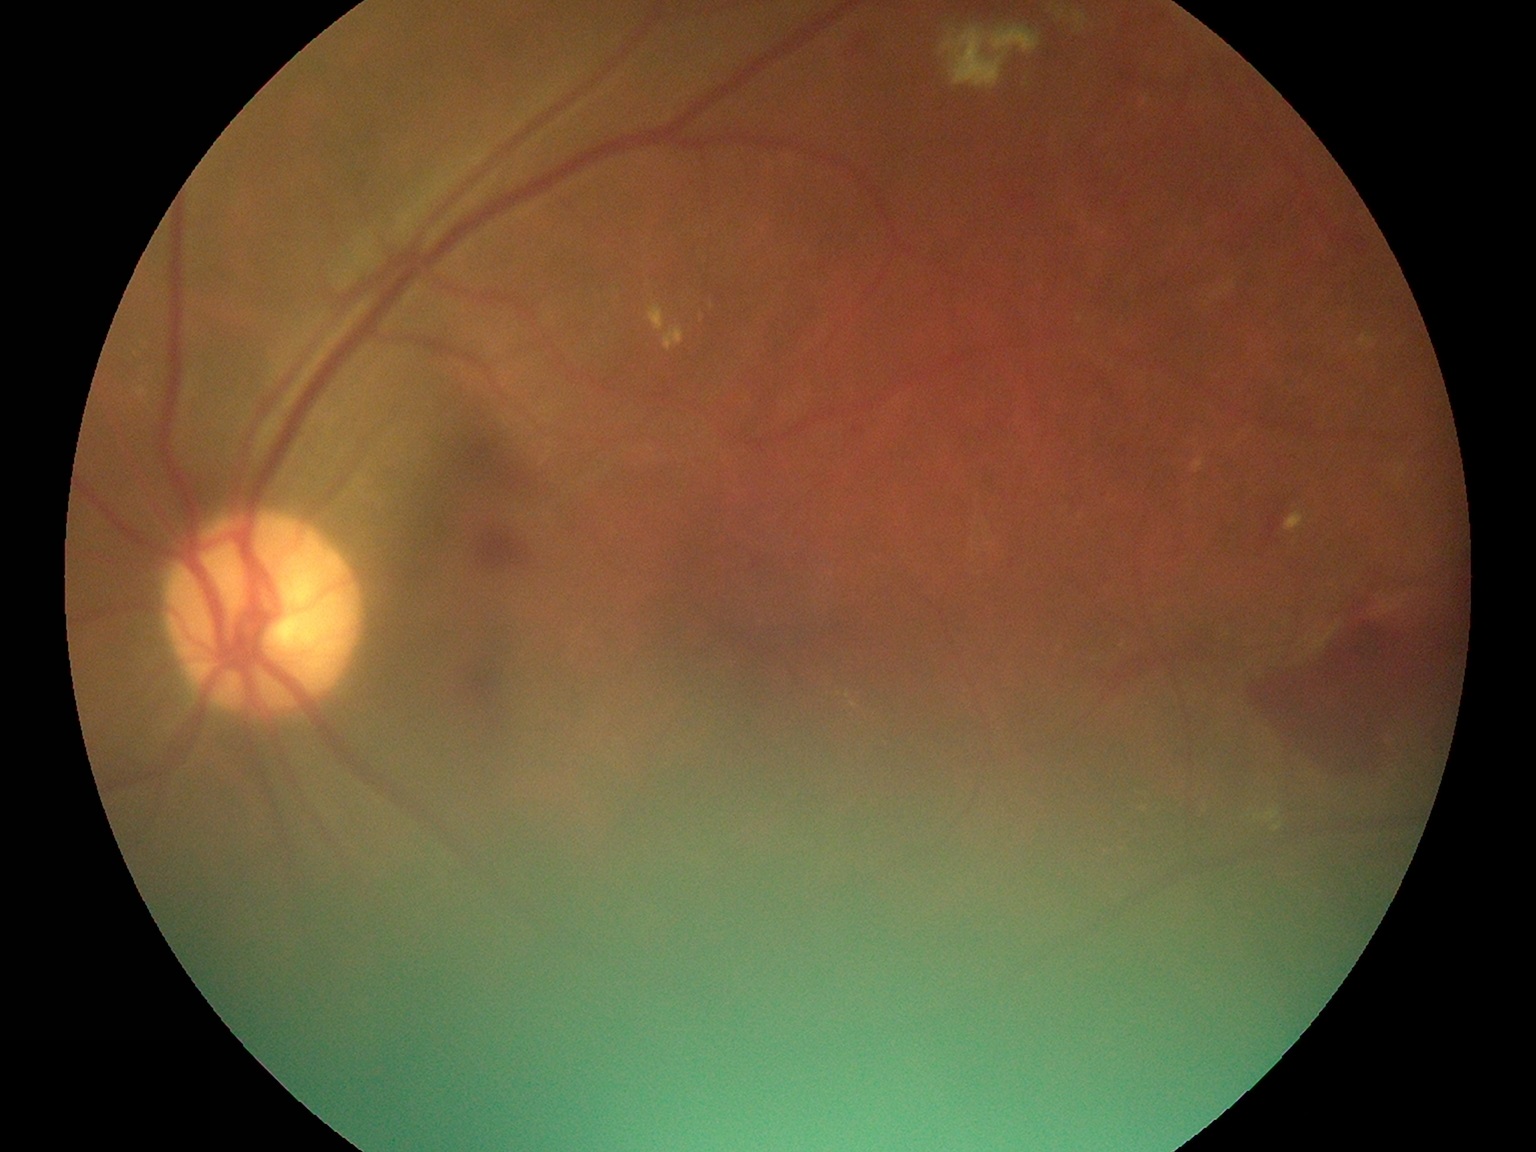

DR stage: grade 4 (PDR).